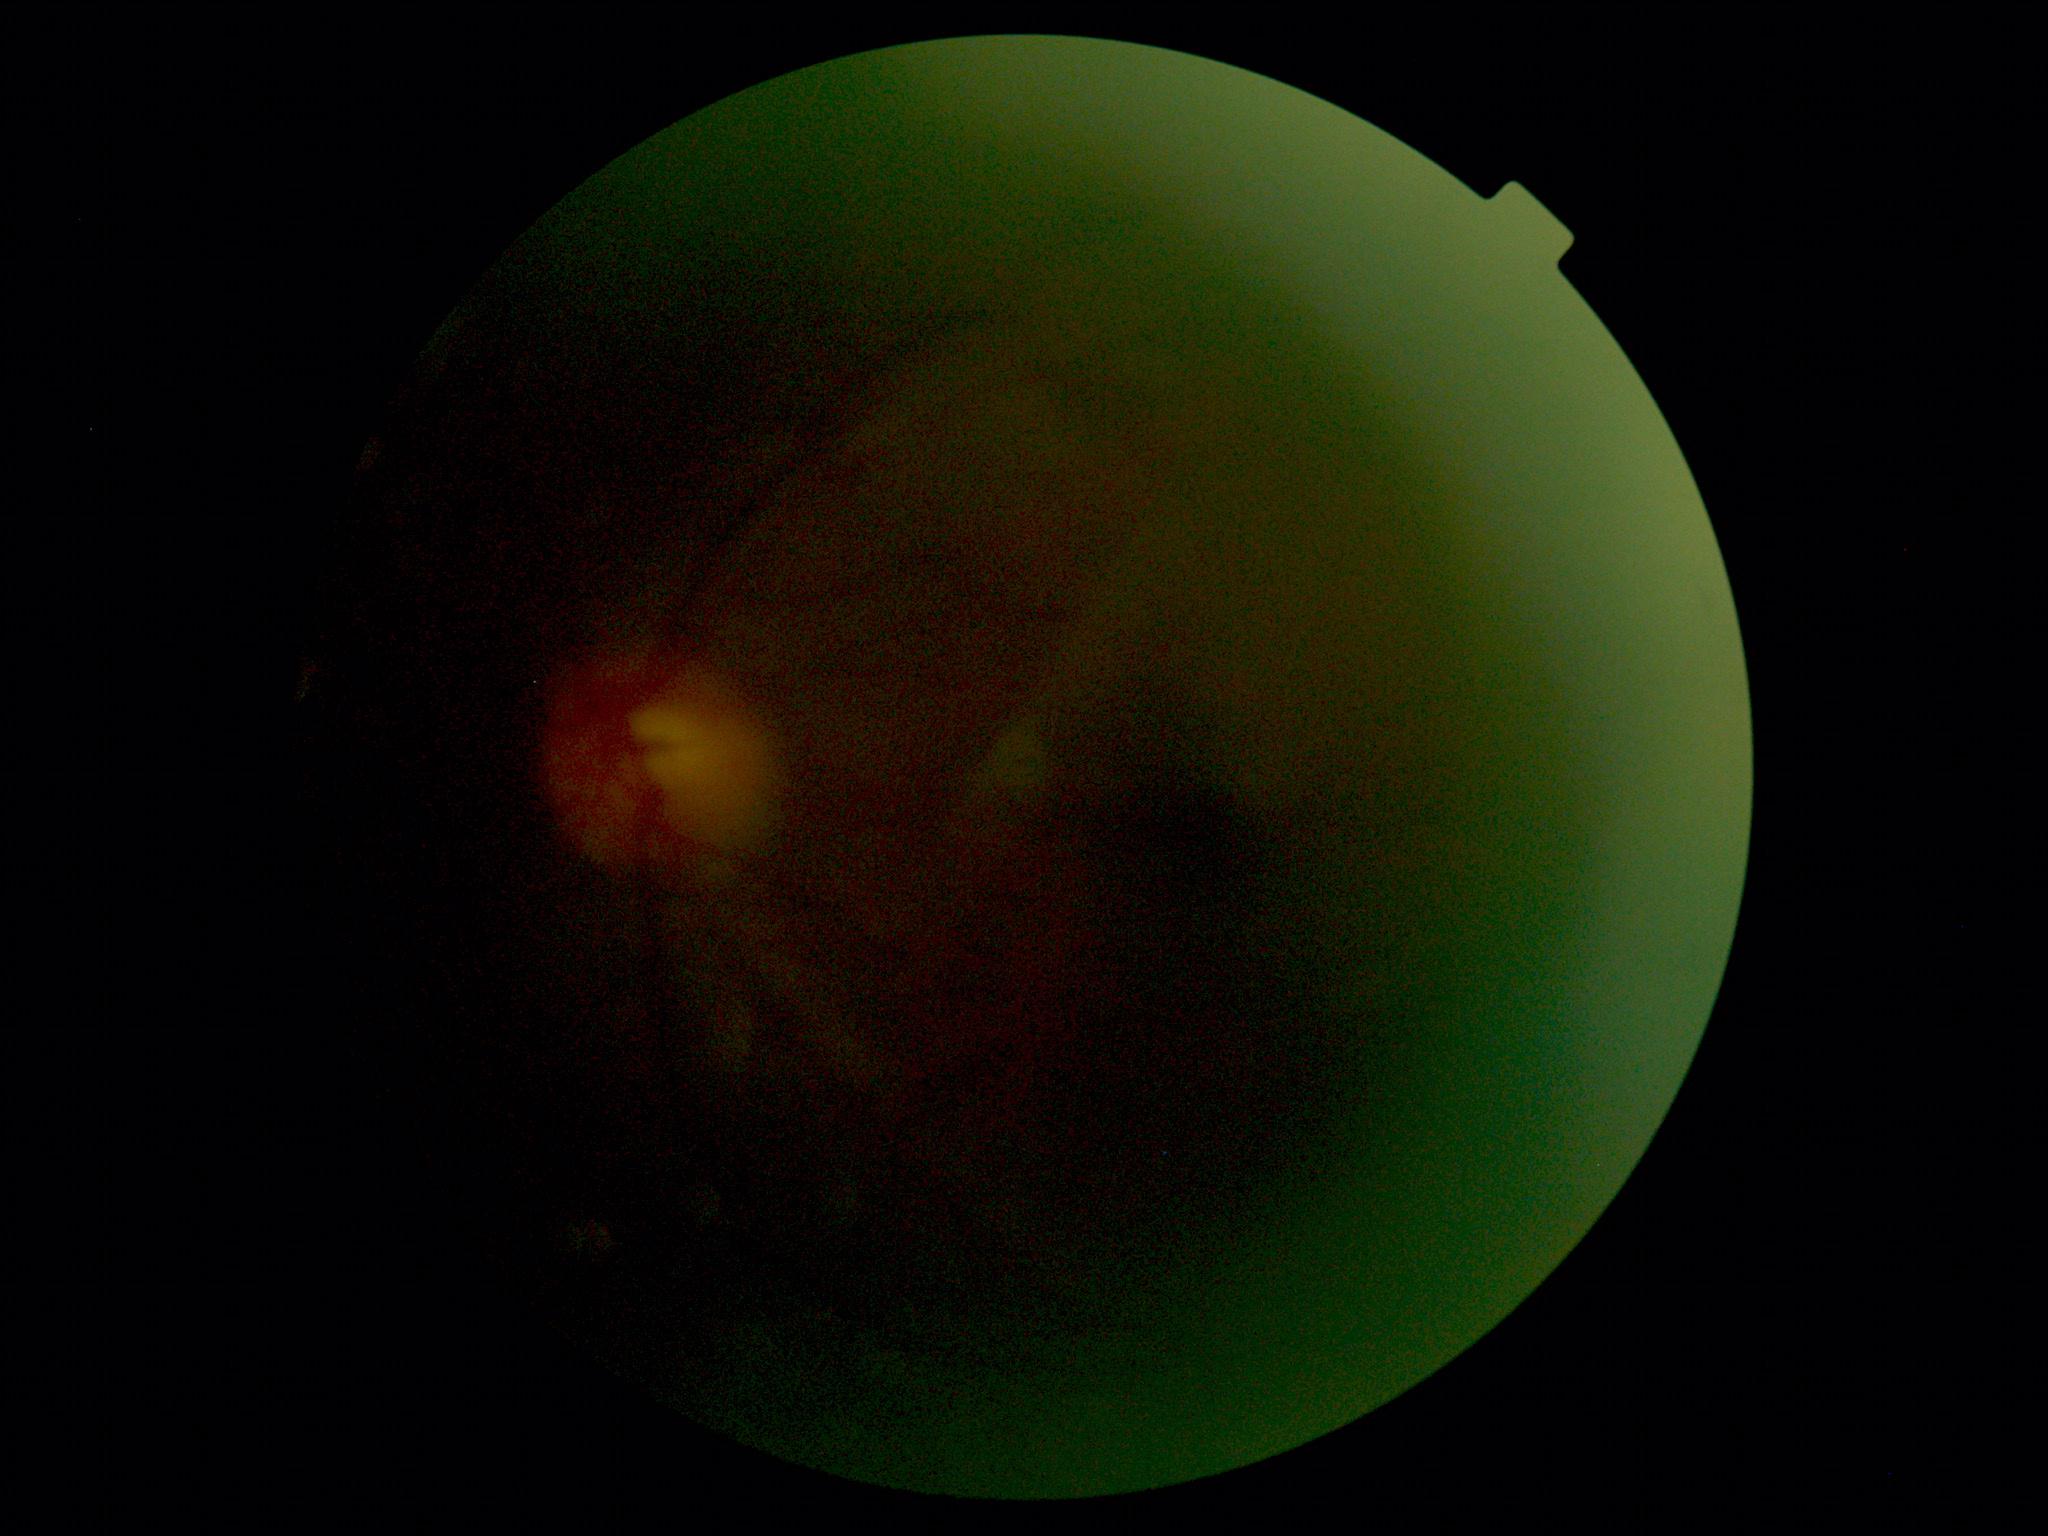
• diabetic retinopathy severity — ungradable